Retinal fundus photograph · 45-degree field of view.
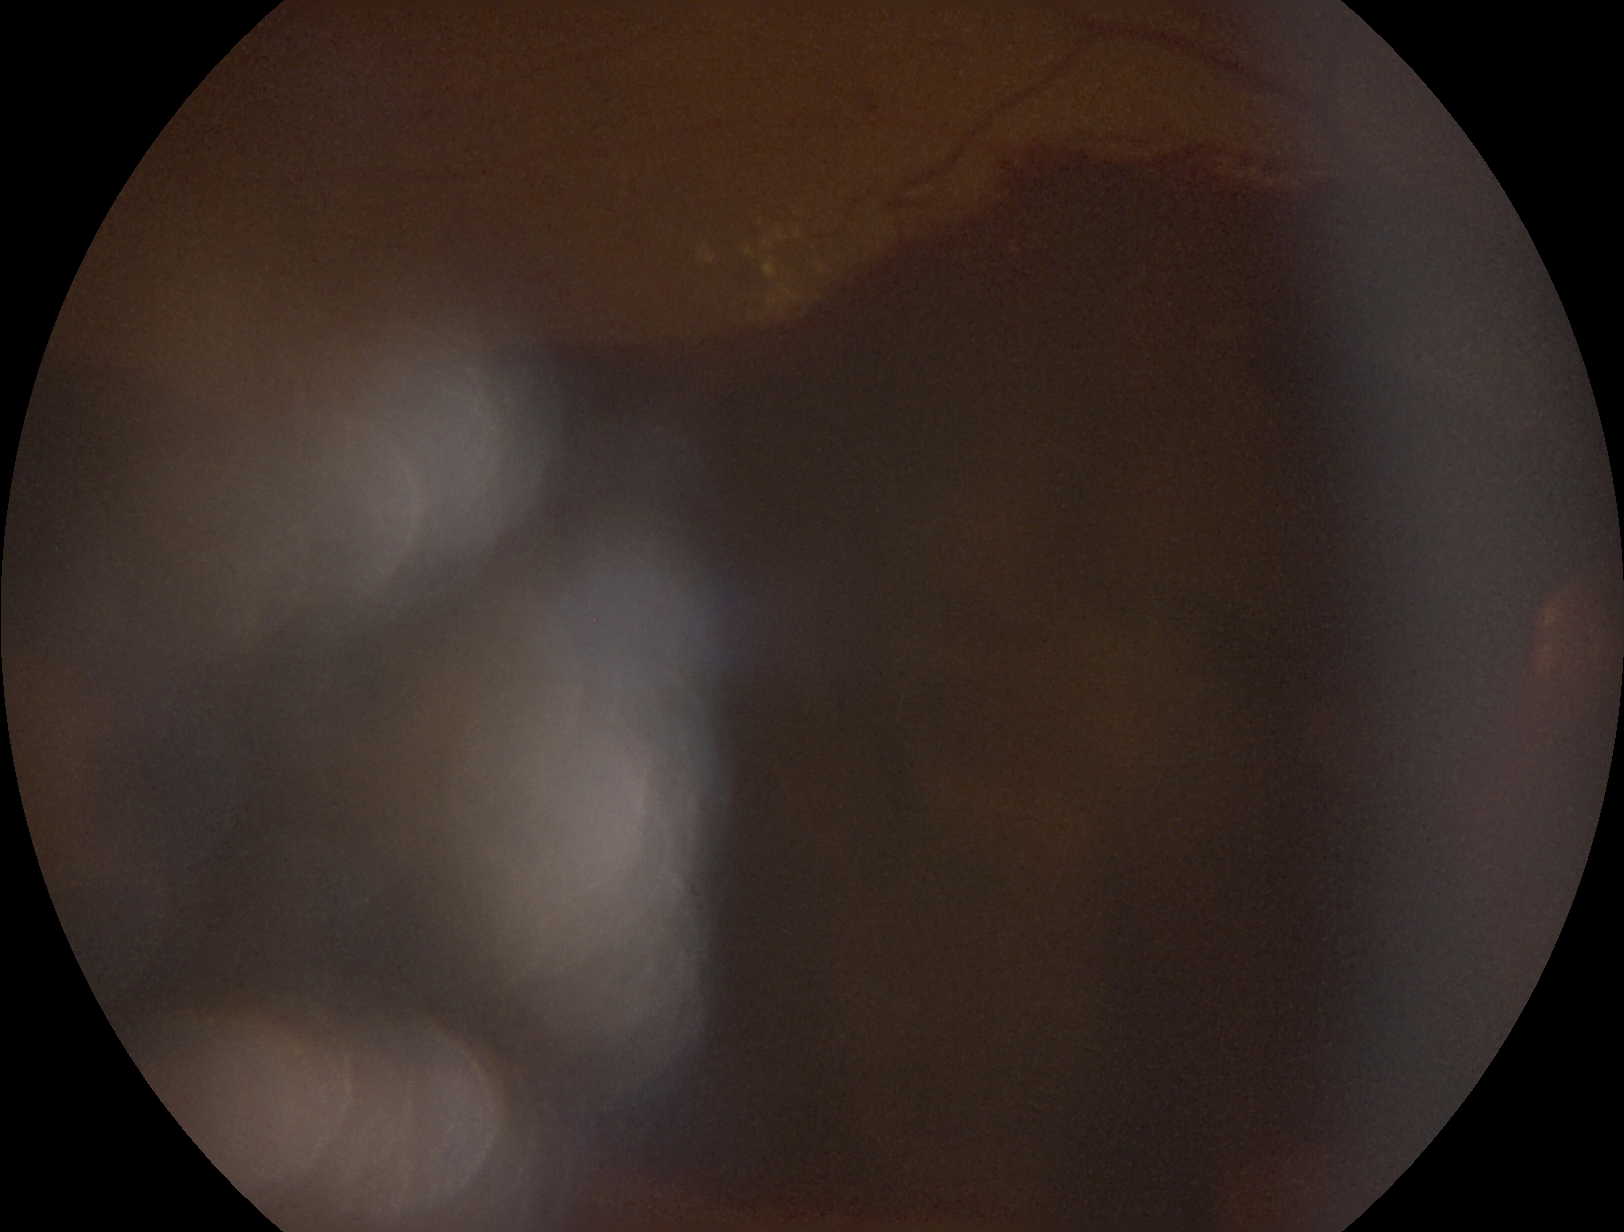 diabetic retinopathy severity = grade 4 (PDR)